2212x1659
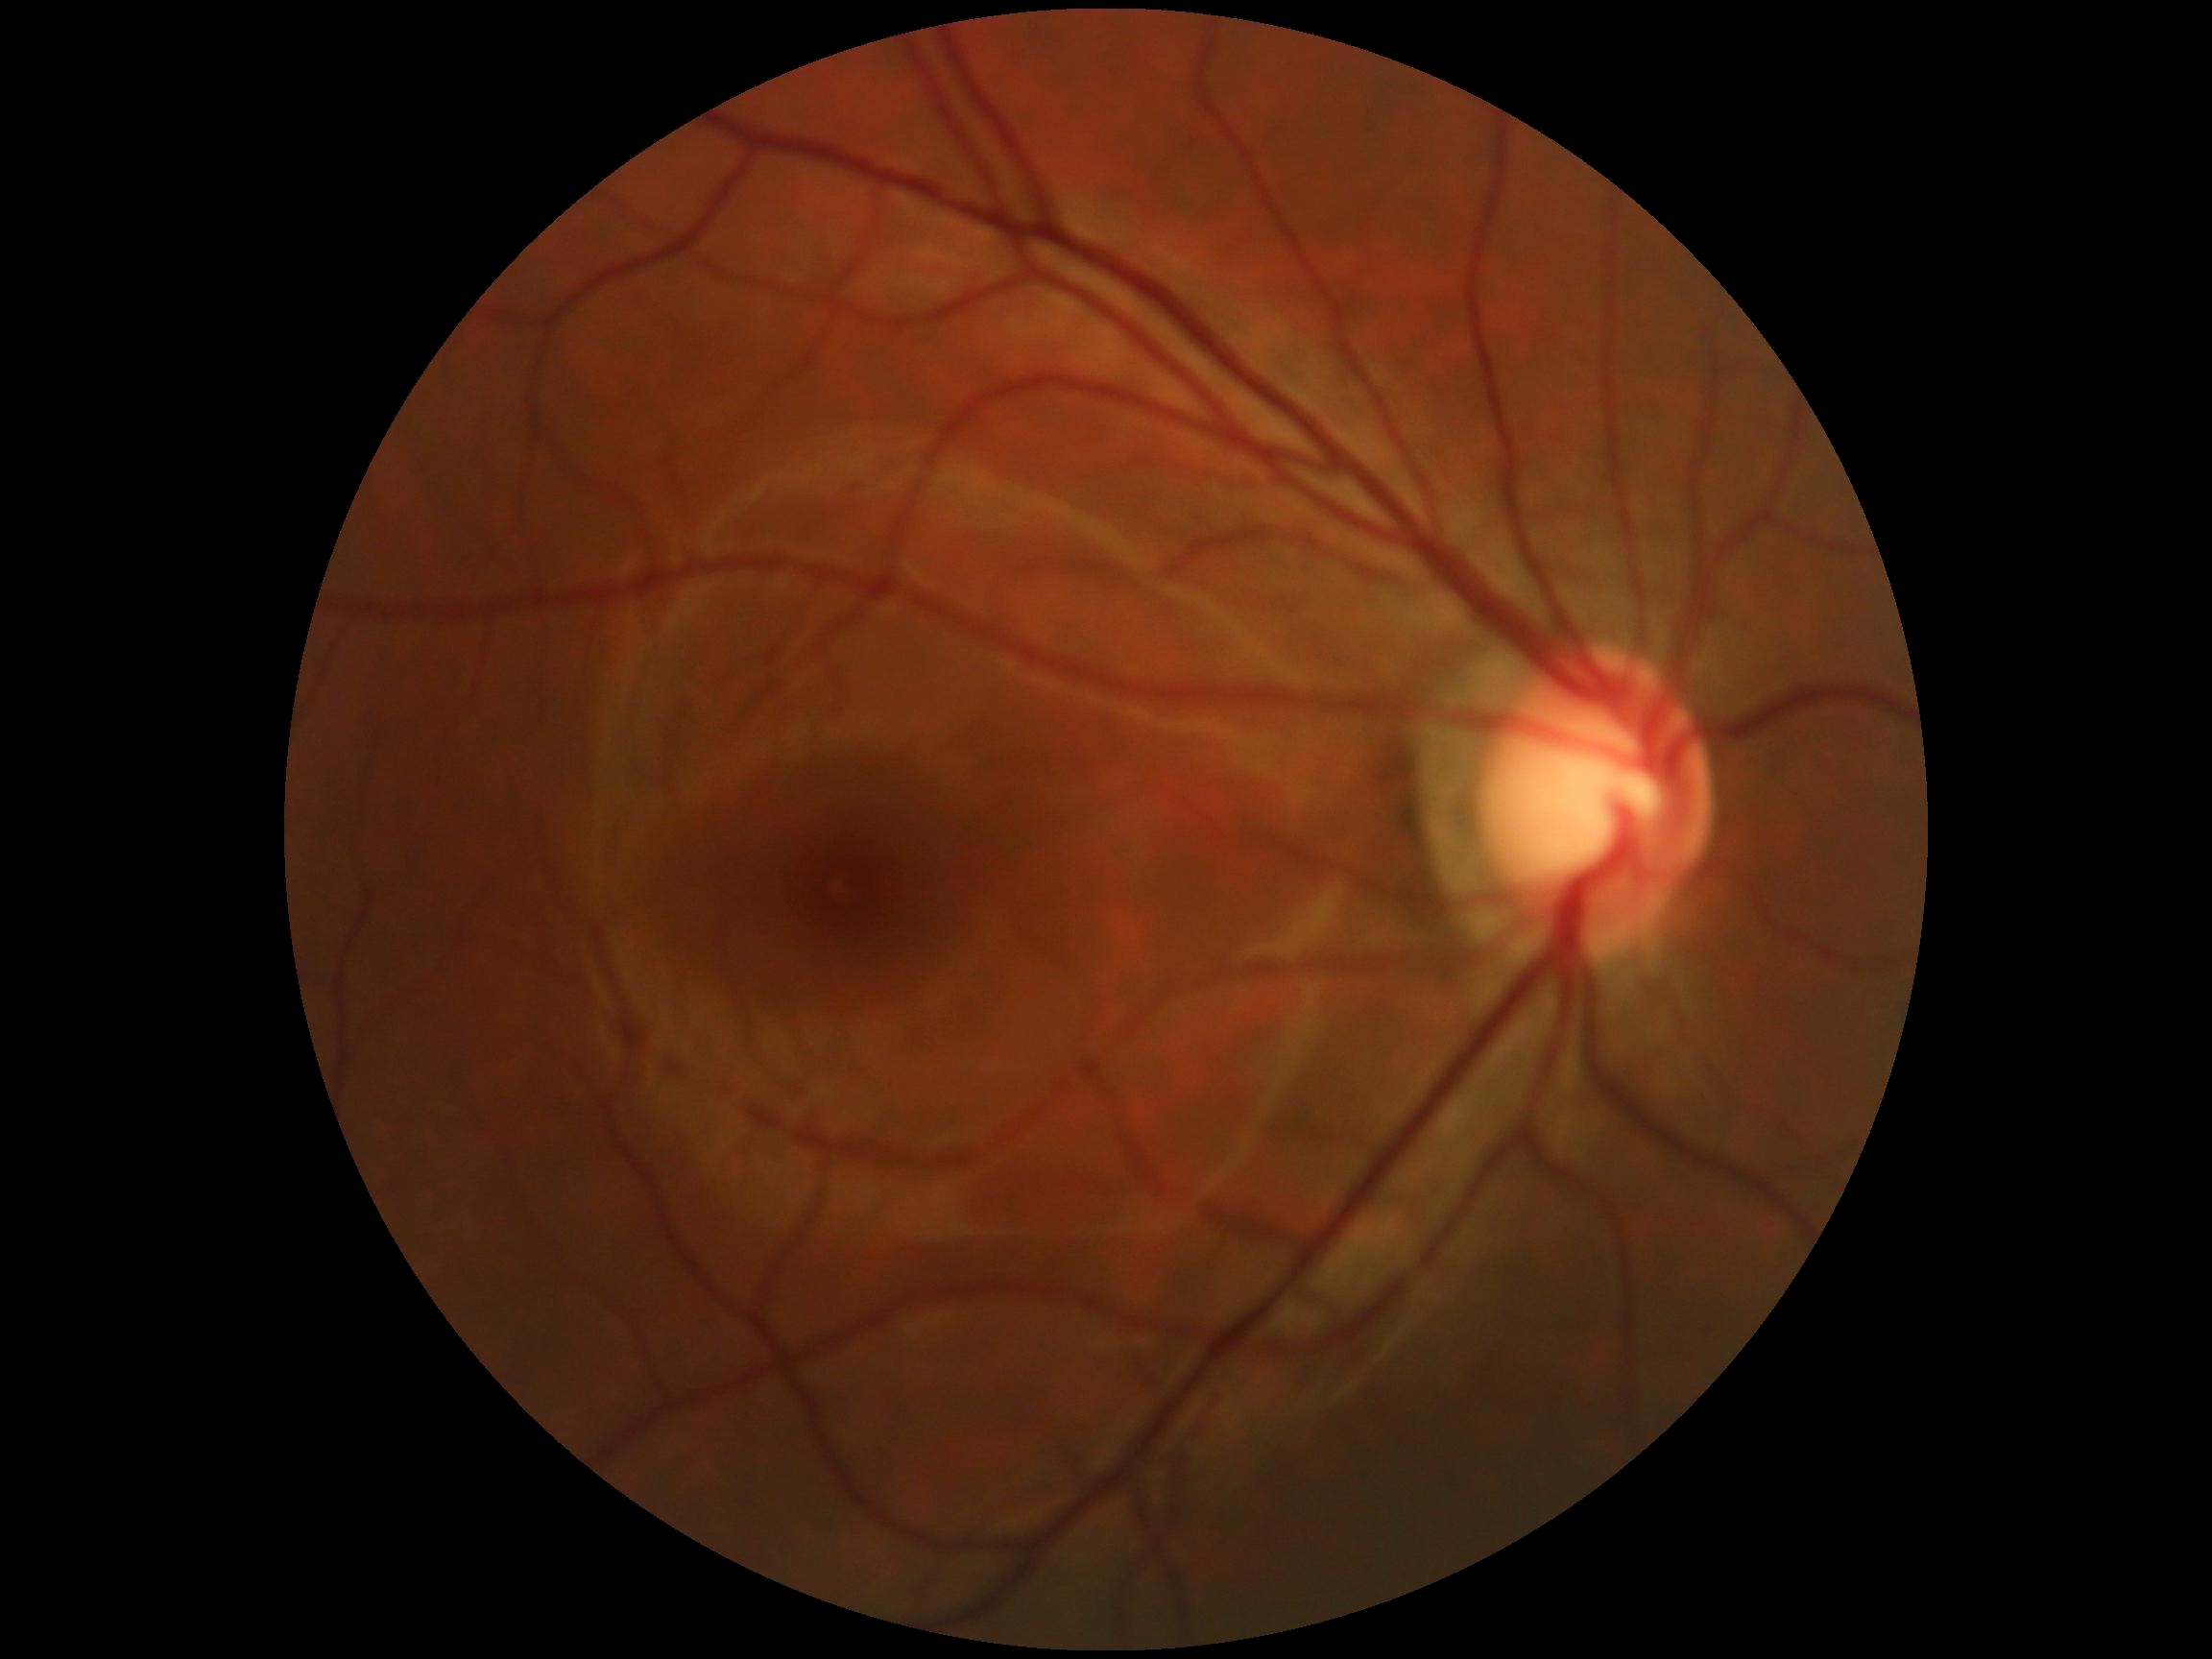 DR is grade 0.